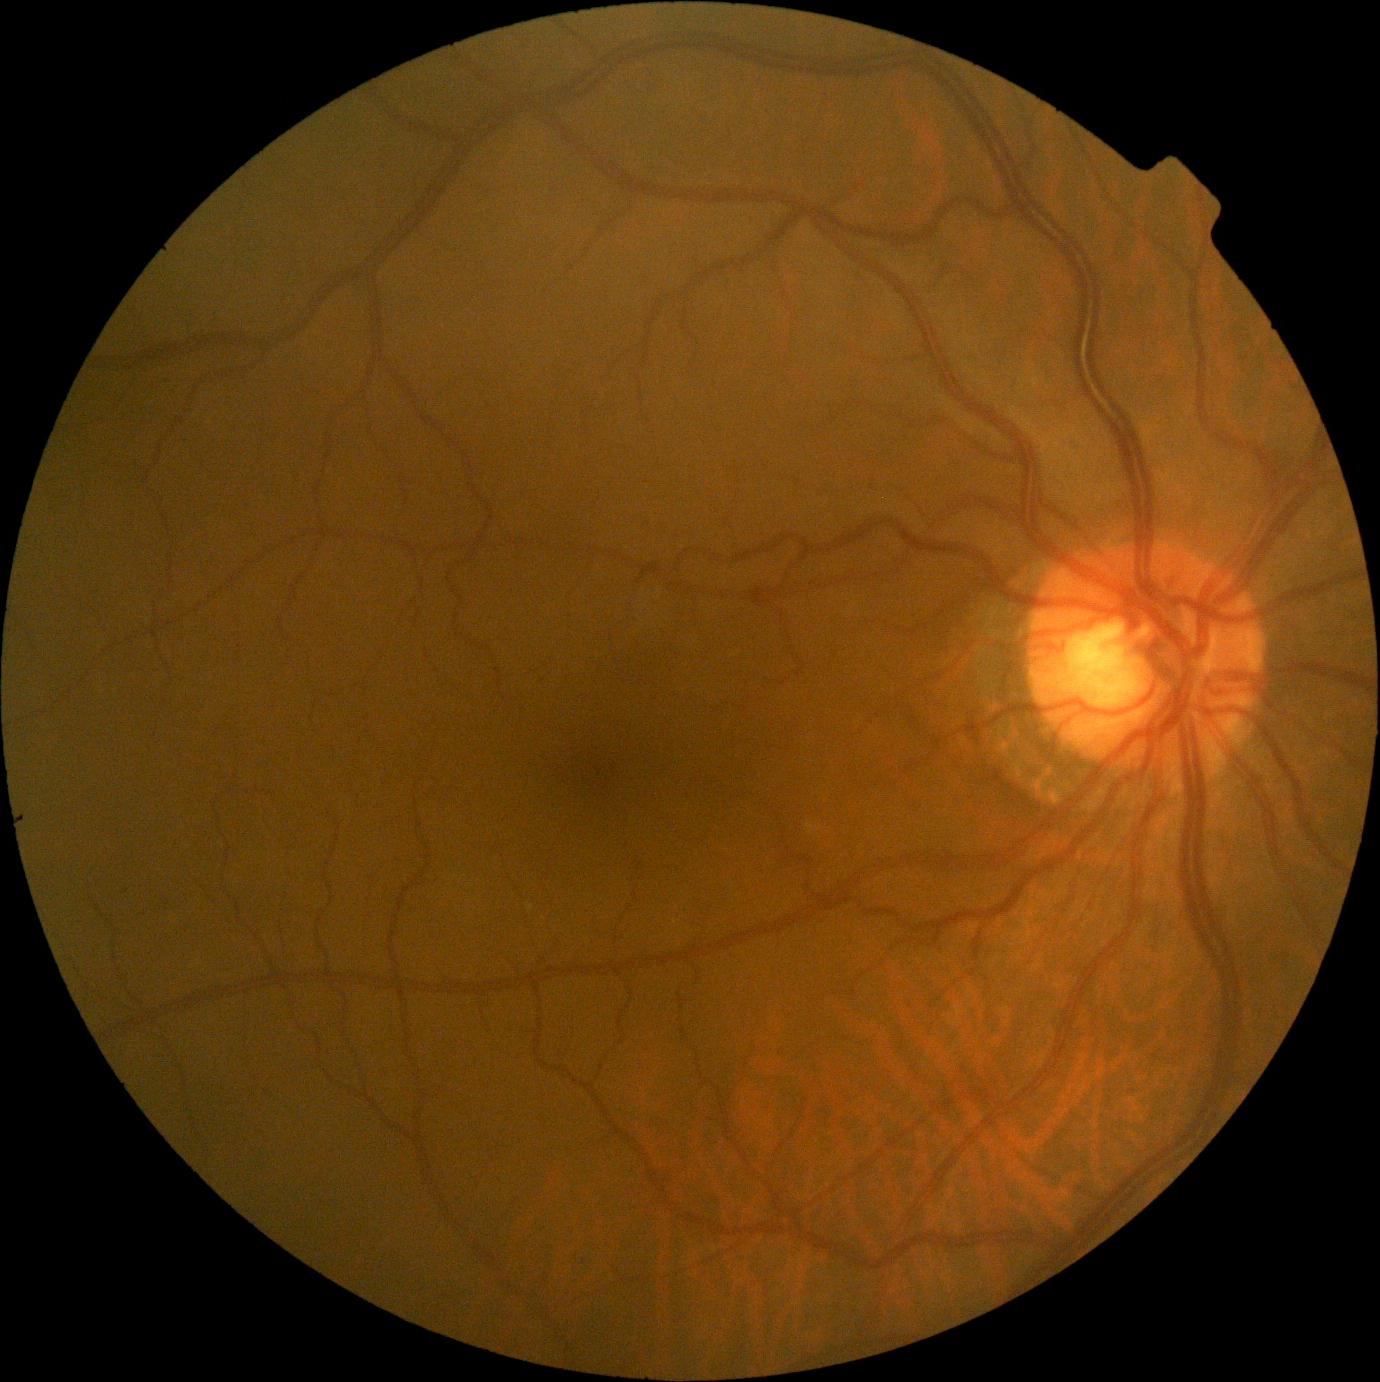

Diabetic retinopathy is 0/4.